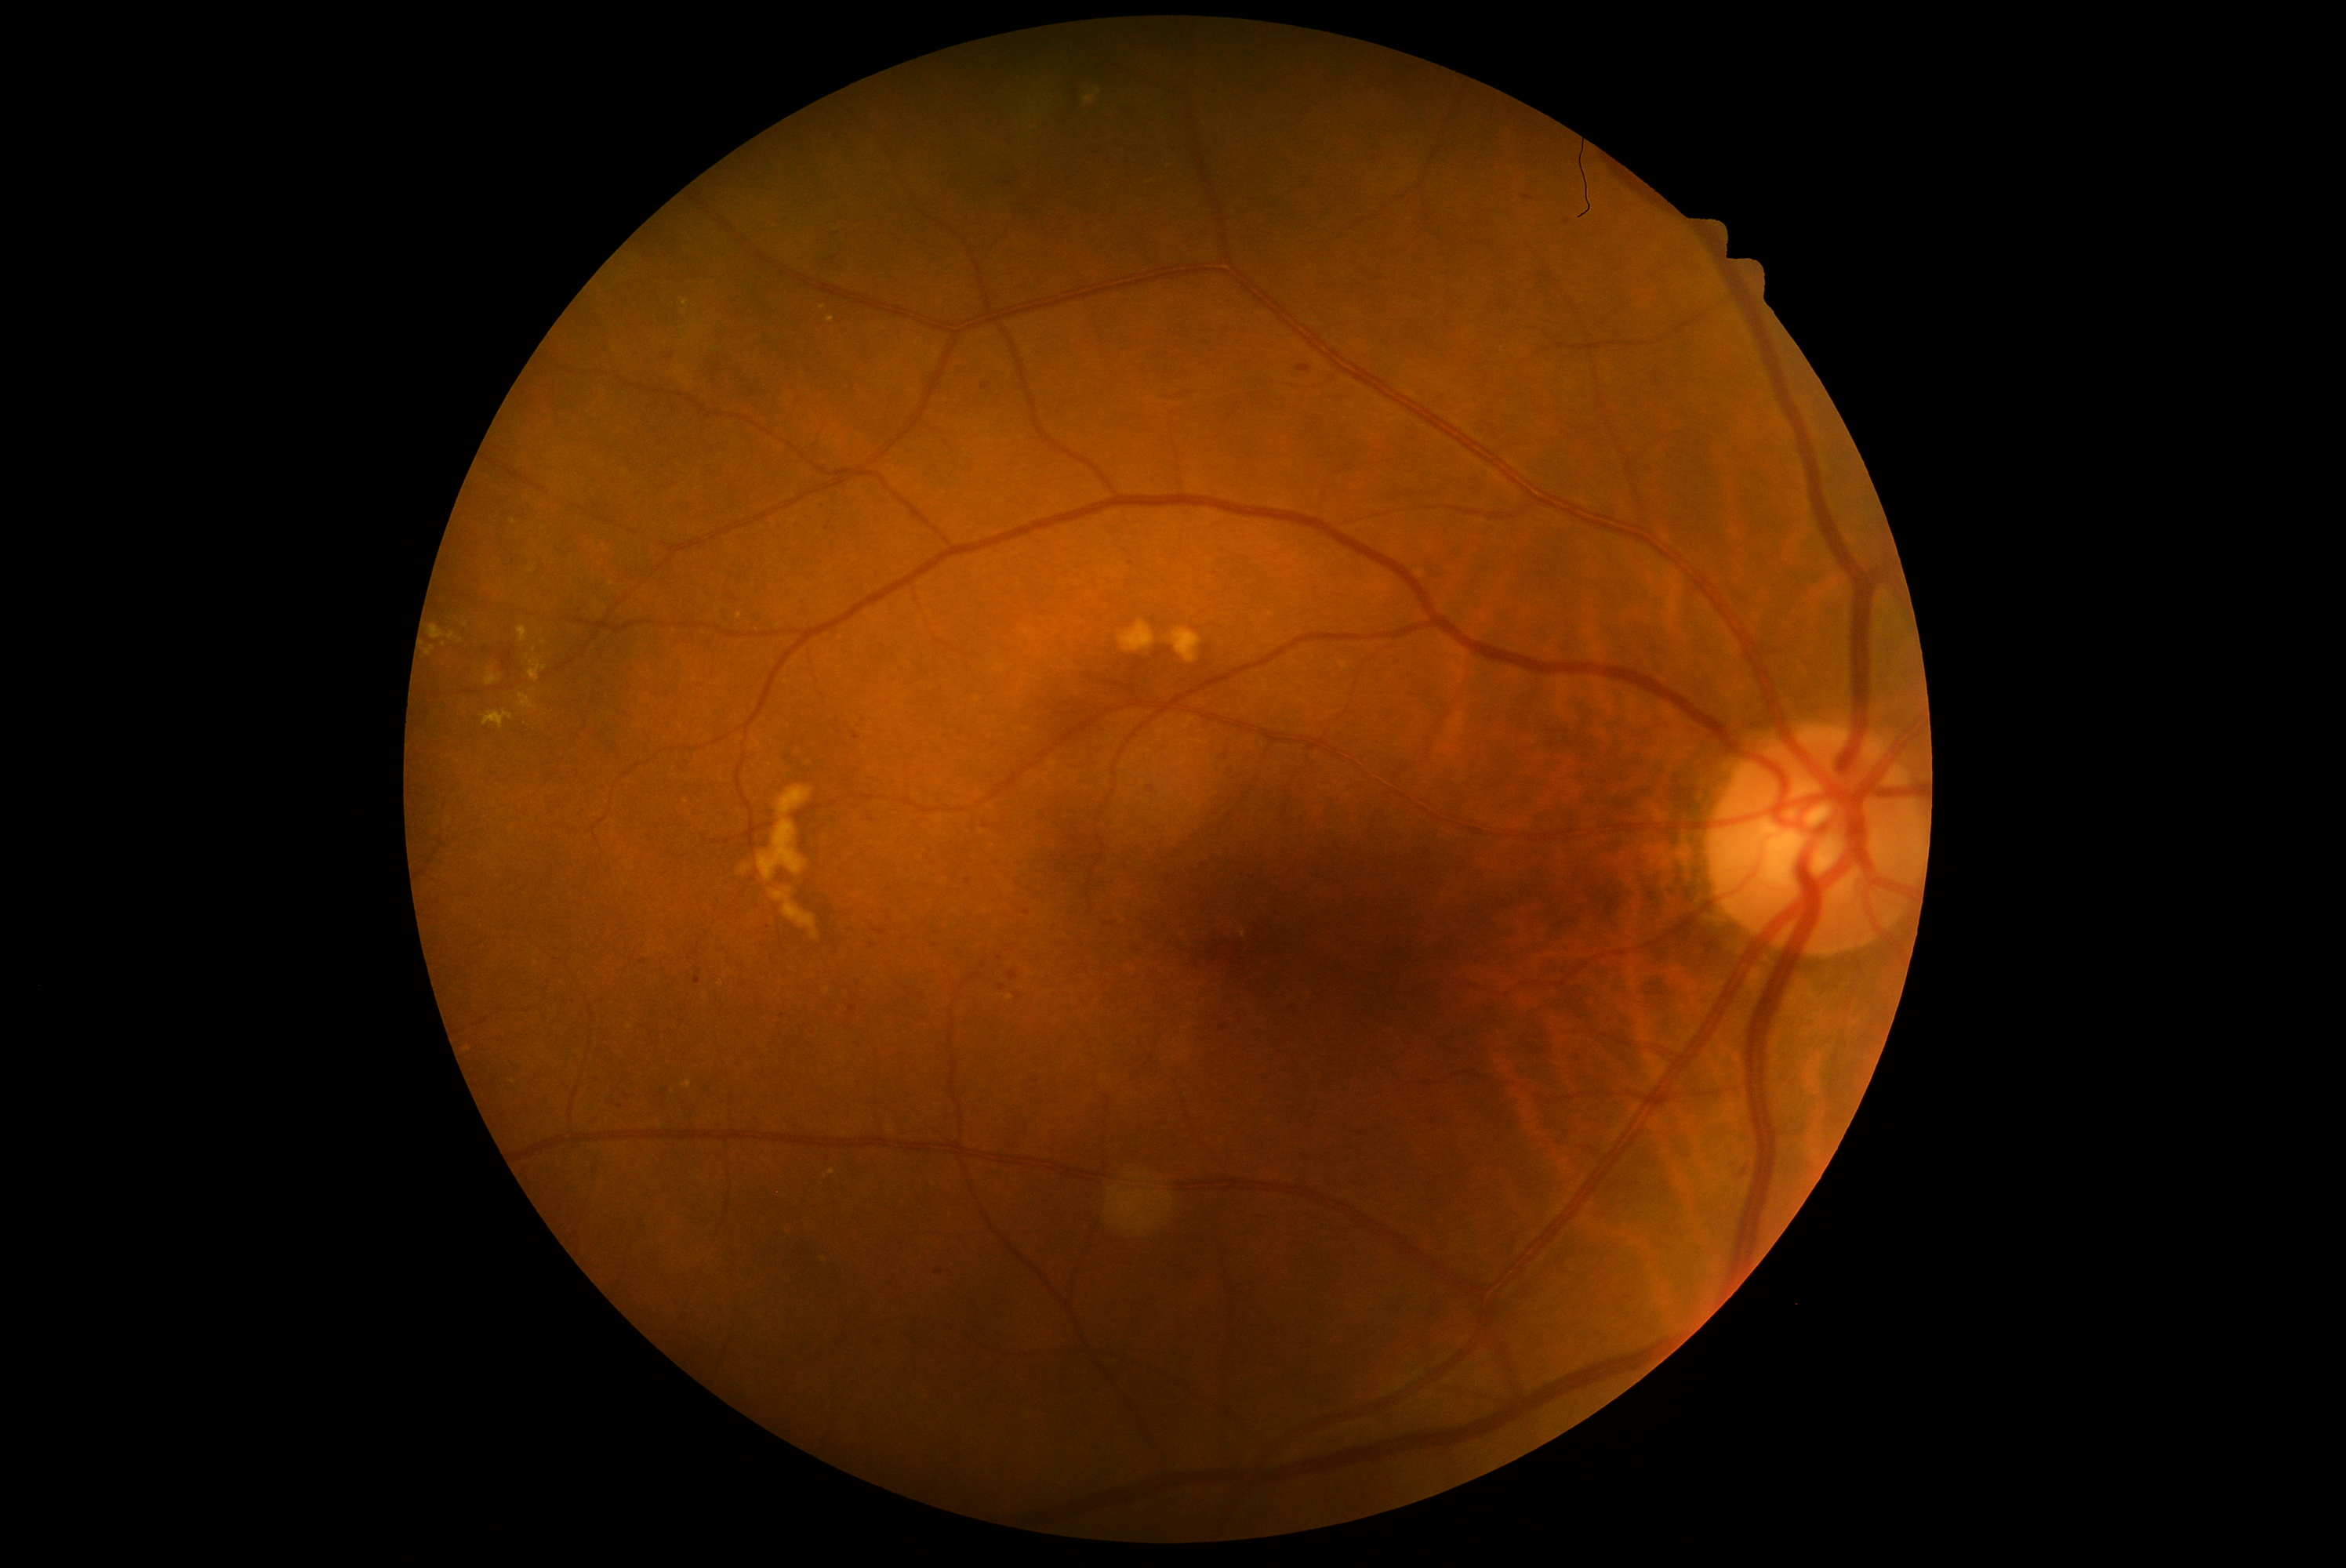 DR is 2. HEs include 870/572/885/583; 503/1058/525/1072; 666/354/675/361; 1354/269/1392/285; 893/236/902/245; 482/647/490/655; 849/1007/857/1014; 924/843/934/854; 1390/655/1406/670. HEs (small, approximate centers) near [1224, 1029]; [1529, 197]; [933, 864]; [650, 835]; [850, 930]; [1654, 278]; [873, 946].